NIDEK AFC-230 fundus camera · image size 848x848 · nonmydriatic fundus photograph · color fundus image · 45 degree fundus photograph · graded on the modified Davis scale
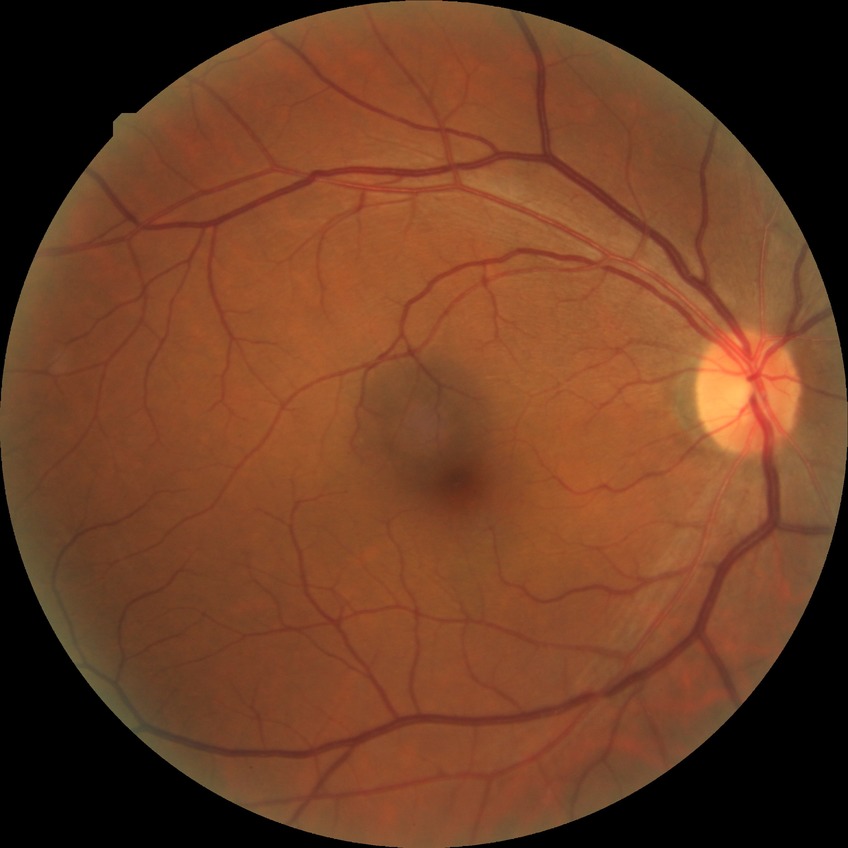

Annotations:
– diabetic retinopathy severity: no diabetic retinopathy